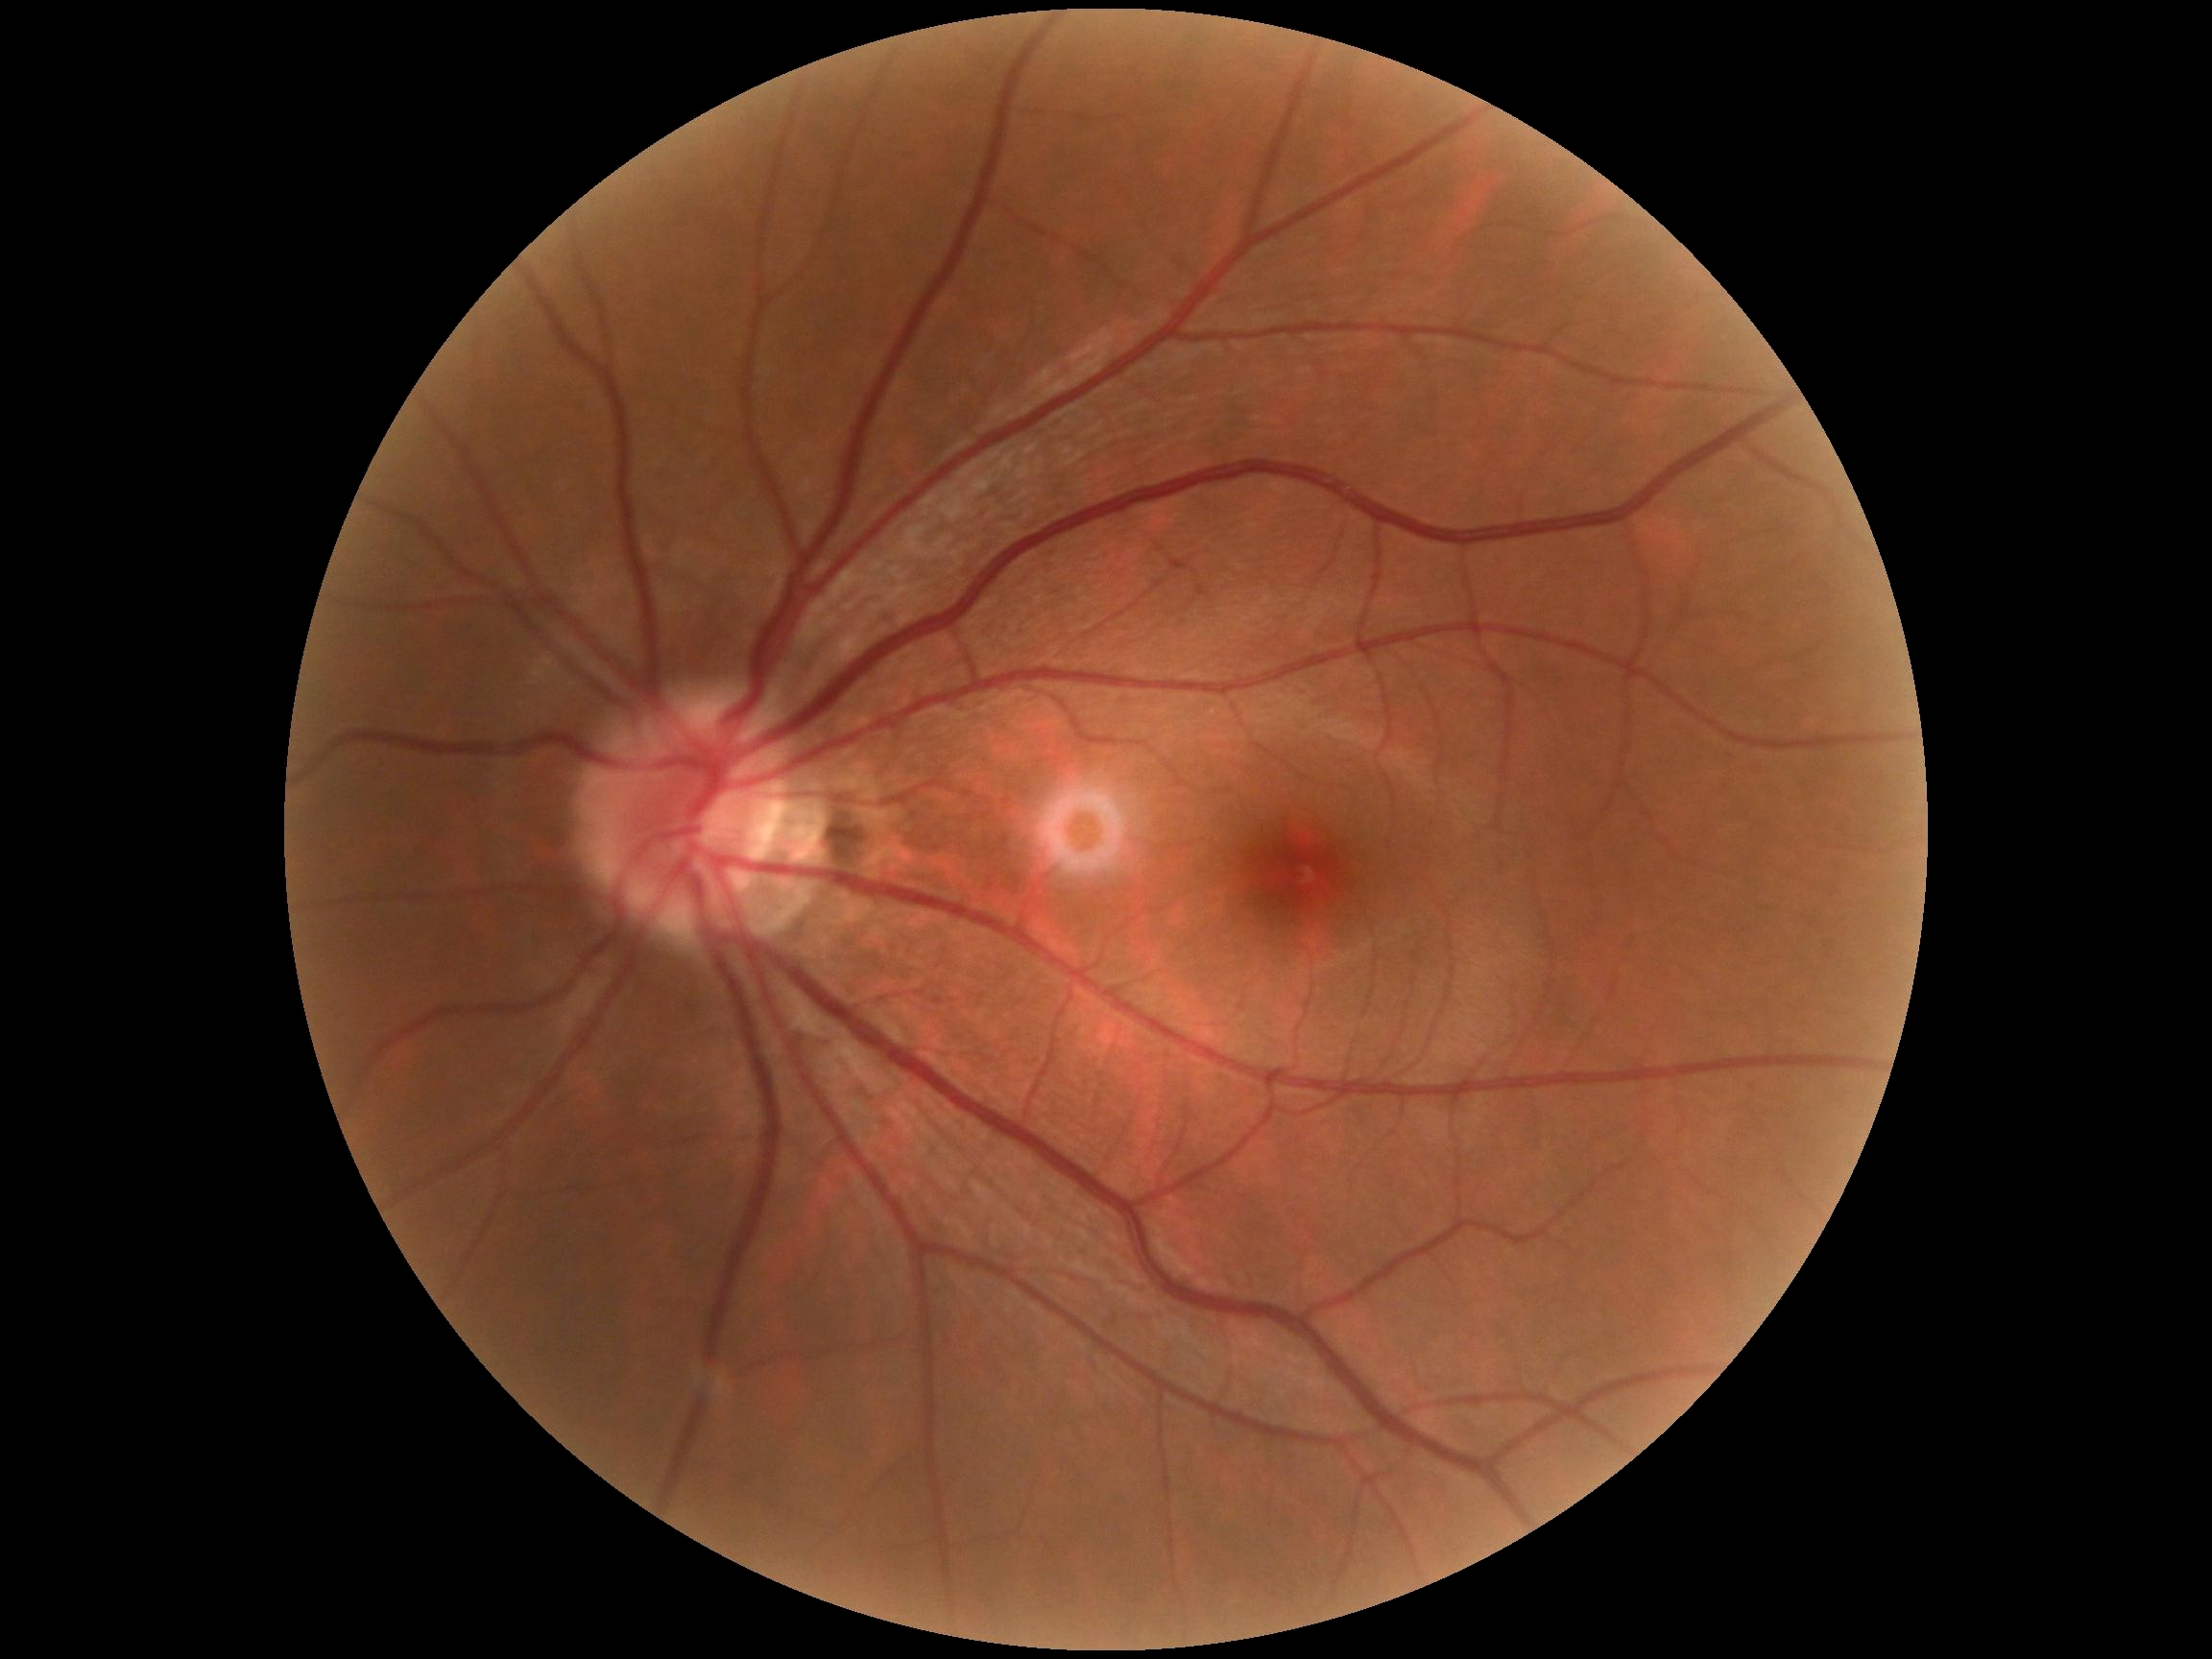 DR grade = 0.